CFP · NIDEK AFC-230 · modified Davis grading.
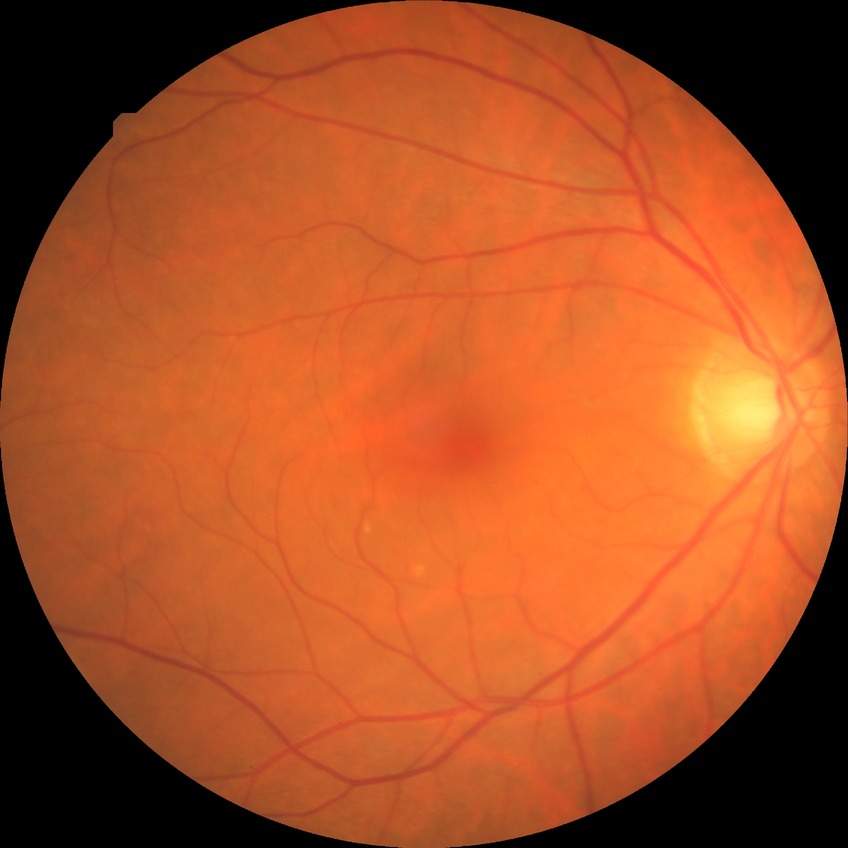 - modified Davis grading: no diabetic retinopathy